848x848px · 45 degree fundus photograph — 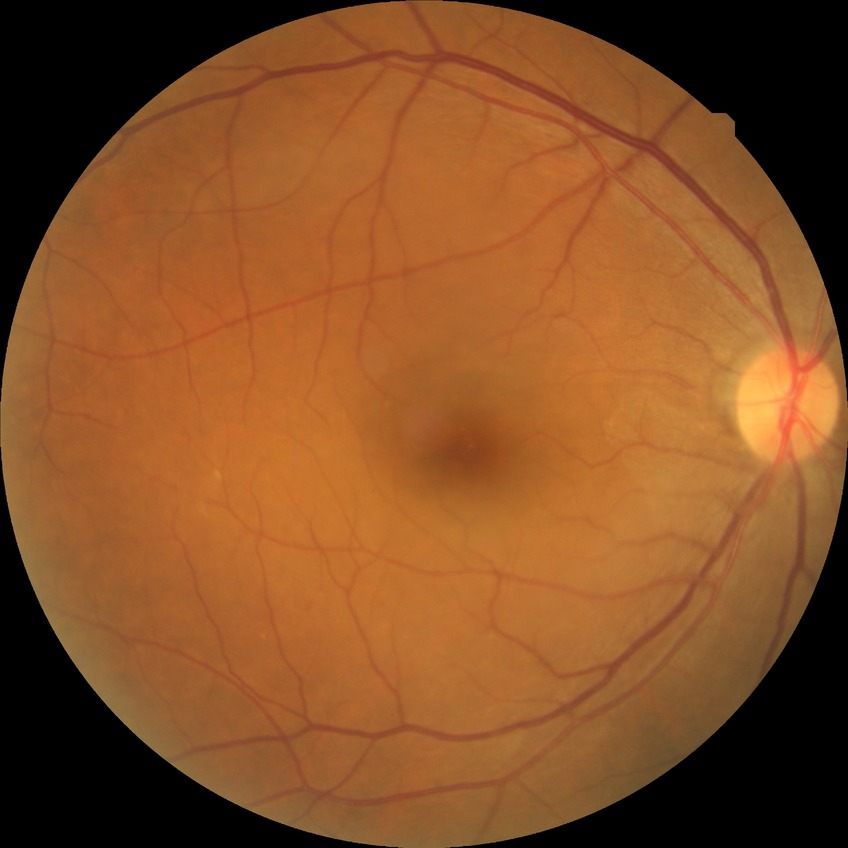

Davis grading: no diabetic retinopathy.